640 by 480 pixels. Wide-field fundus photograph of an infant.
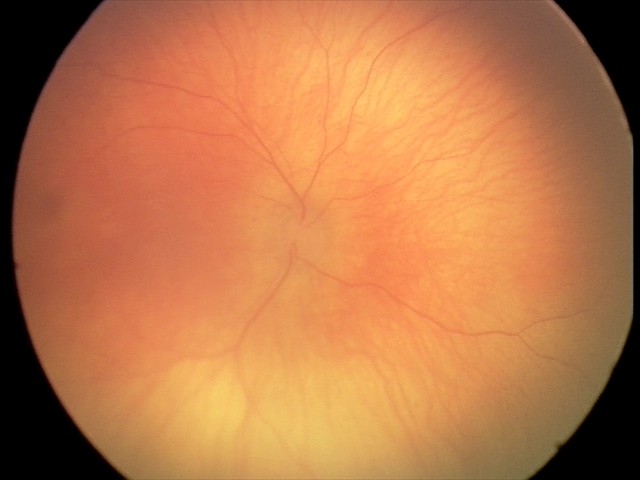
Normal screening examination.